Davis DR grading · FOV: 45 degrees: 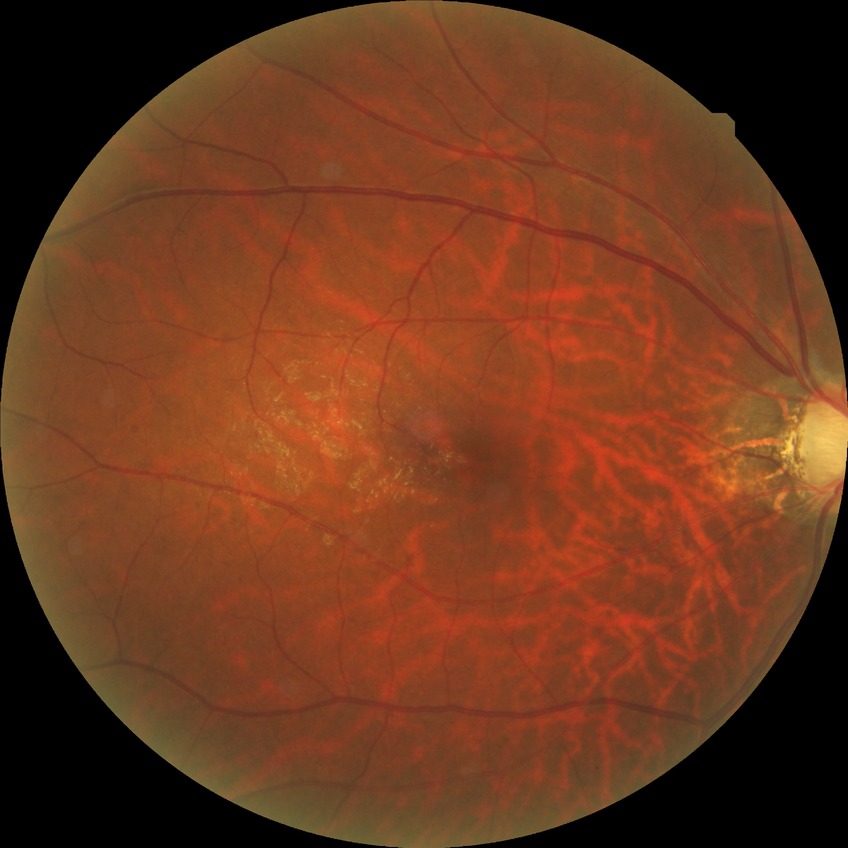
Diabetic retinopathy (DR): NDR (no diabetic retinopathy).